Image size 848x848, graded on the modified Davis scale — 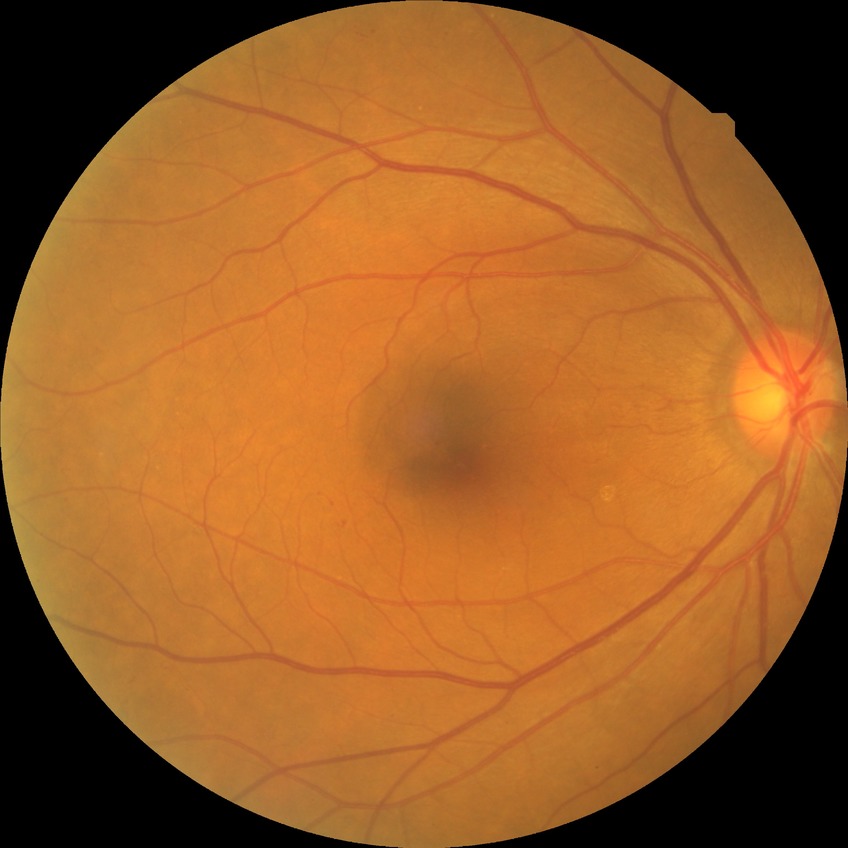

DR class@non-proliferative diabetic retinopathy, diabetic retinopathy (DR)@SDR (simple diabetic retinopathy).